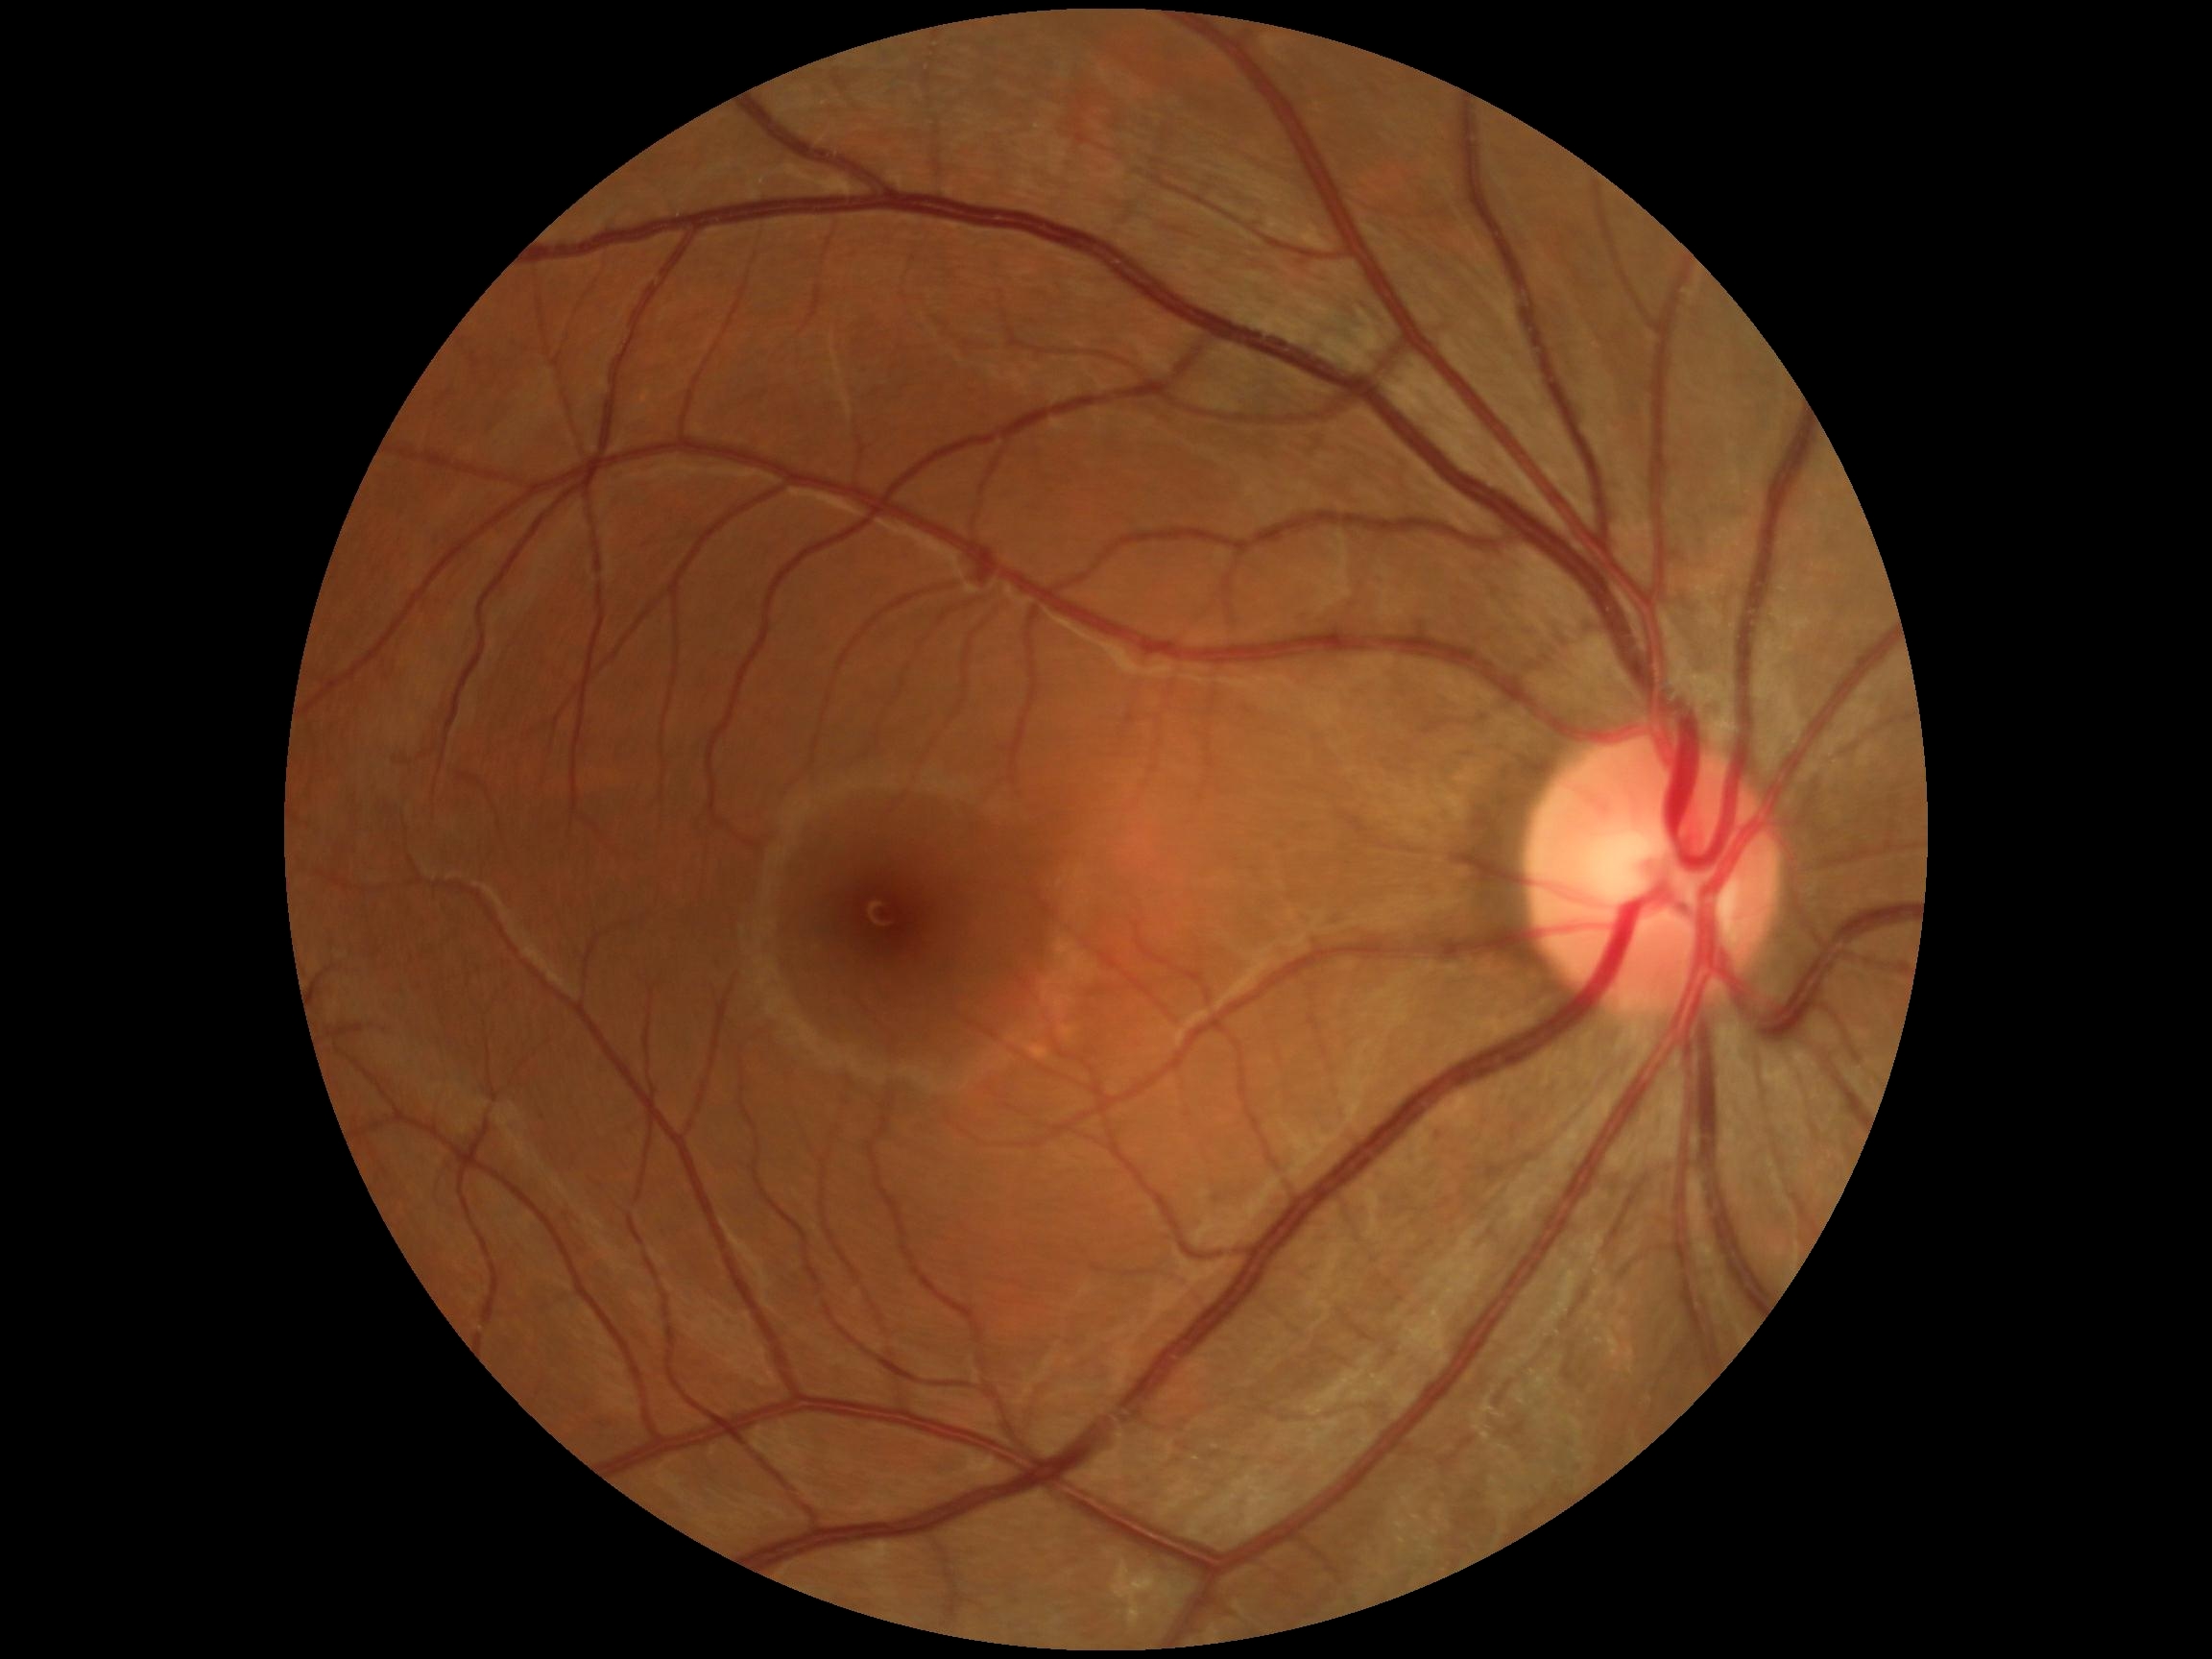

Diabetic retinopathy grade: 0.
No DR findings.